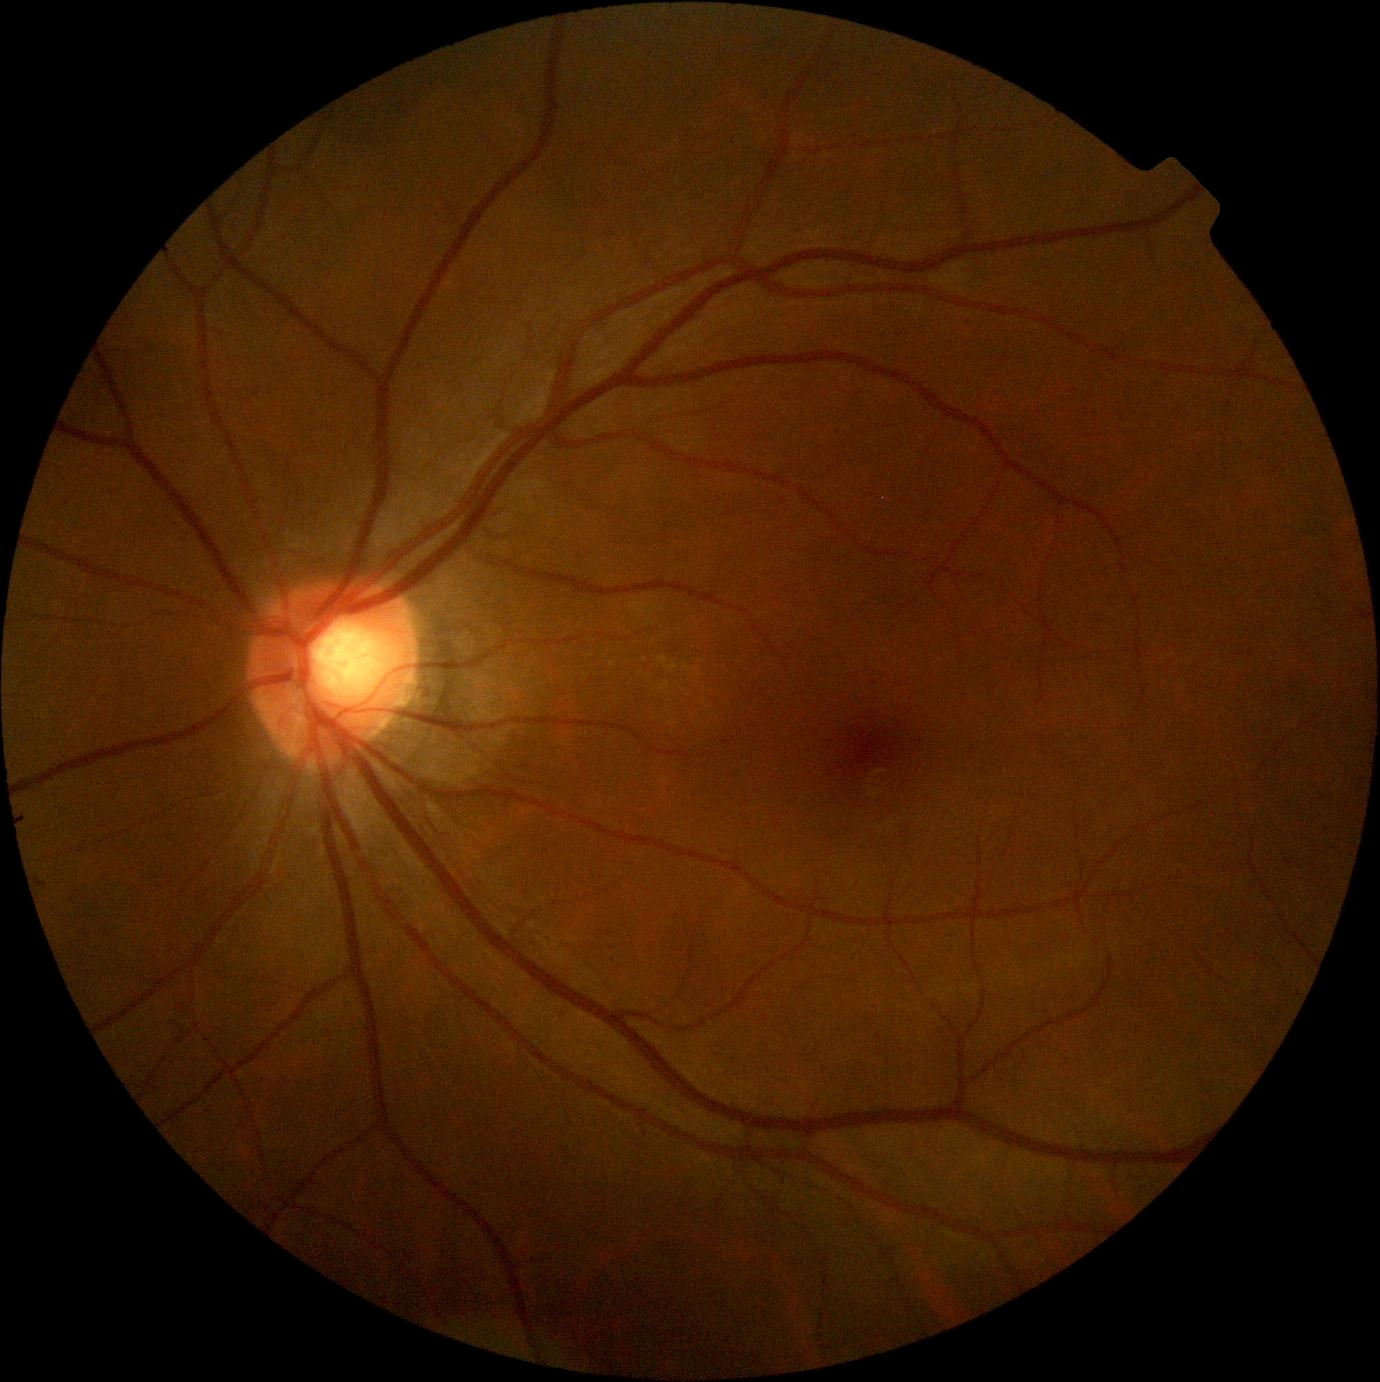
retinopathy = grade 0 (no apparent retinopathy).